45° field of view.
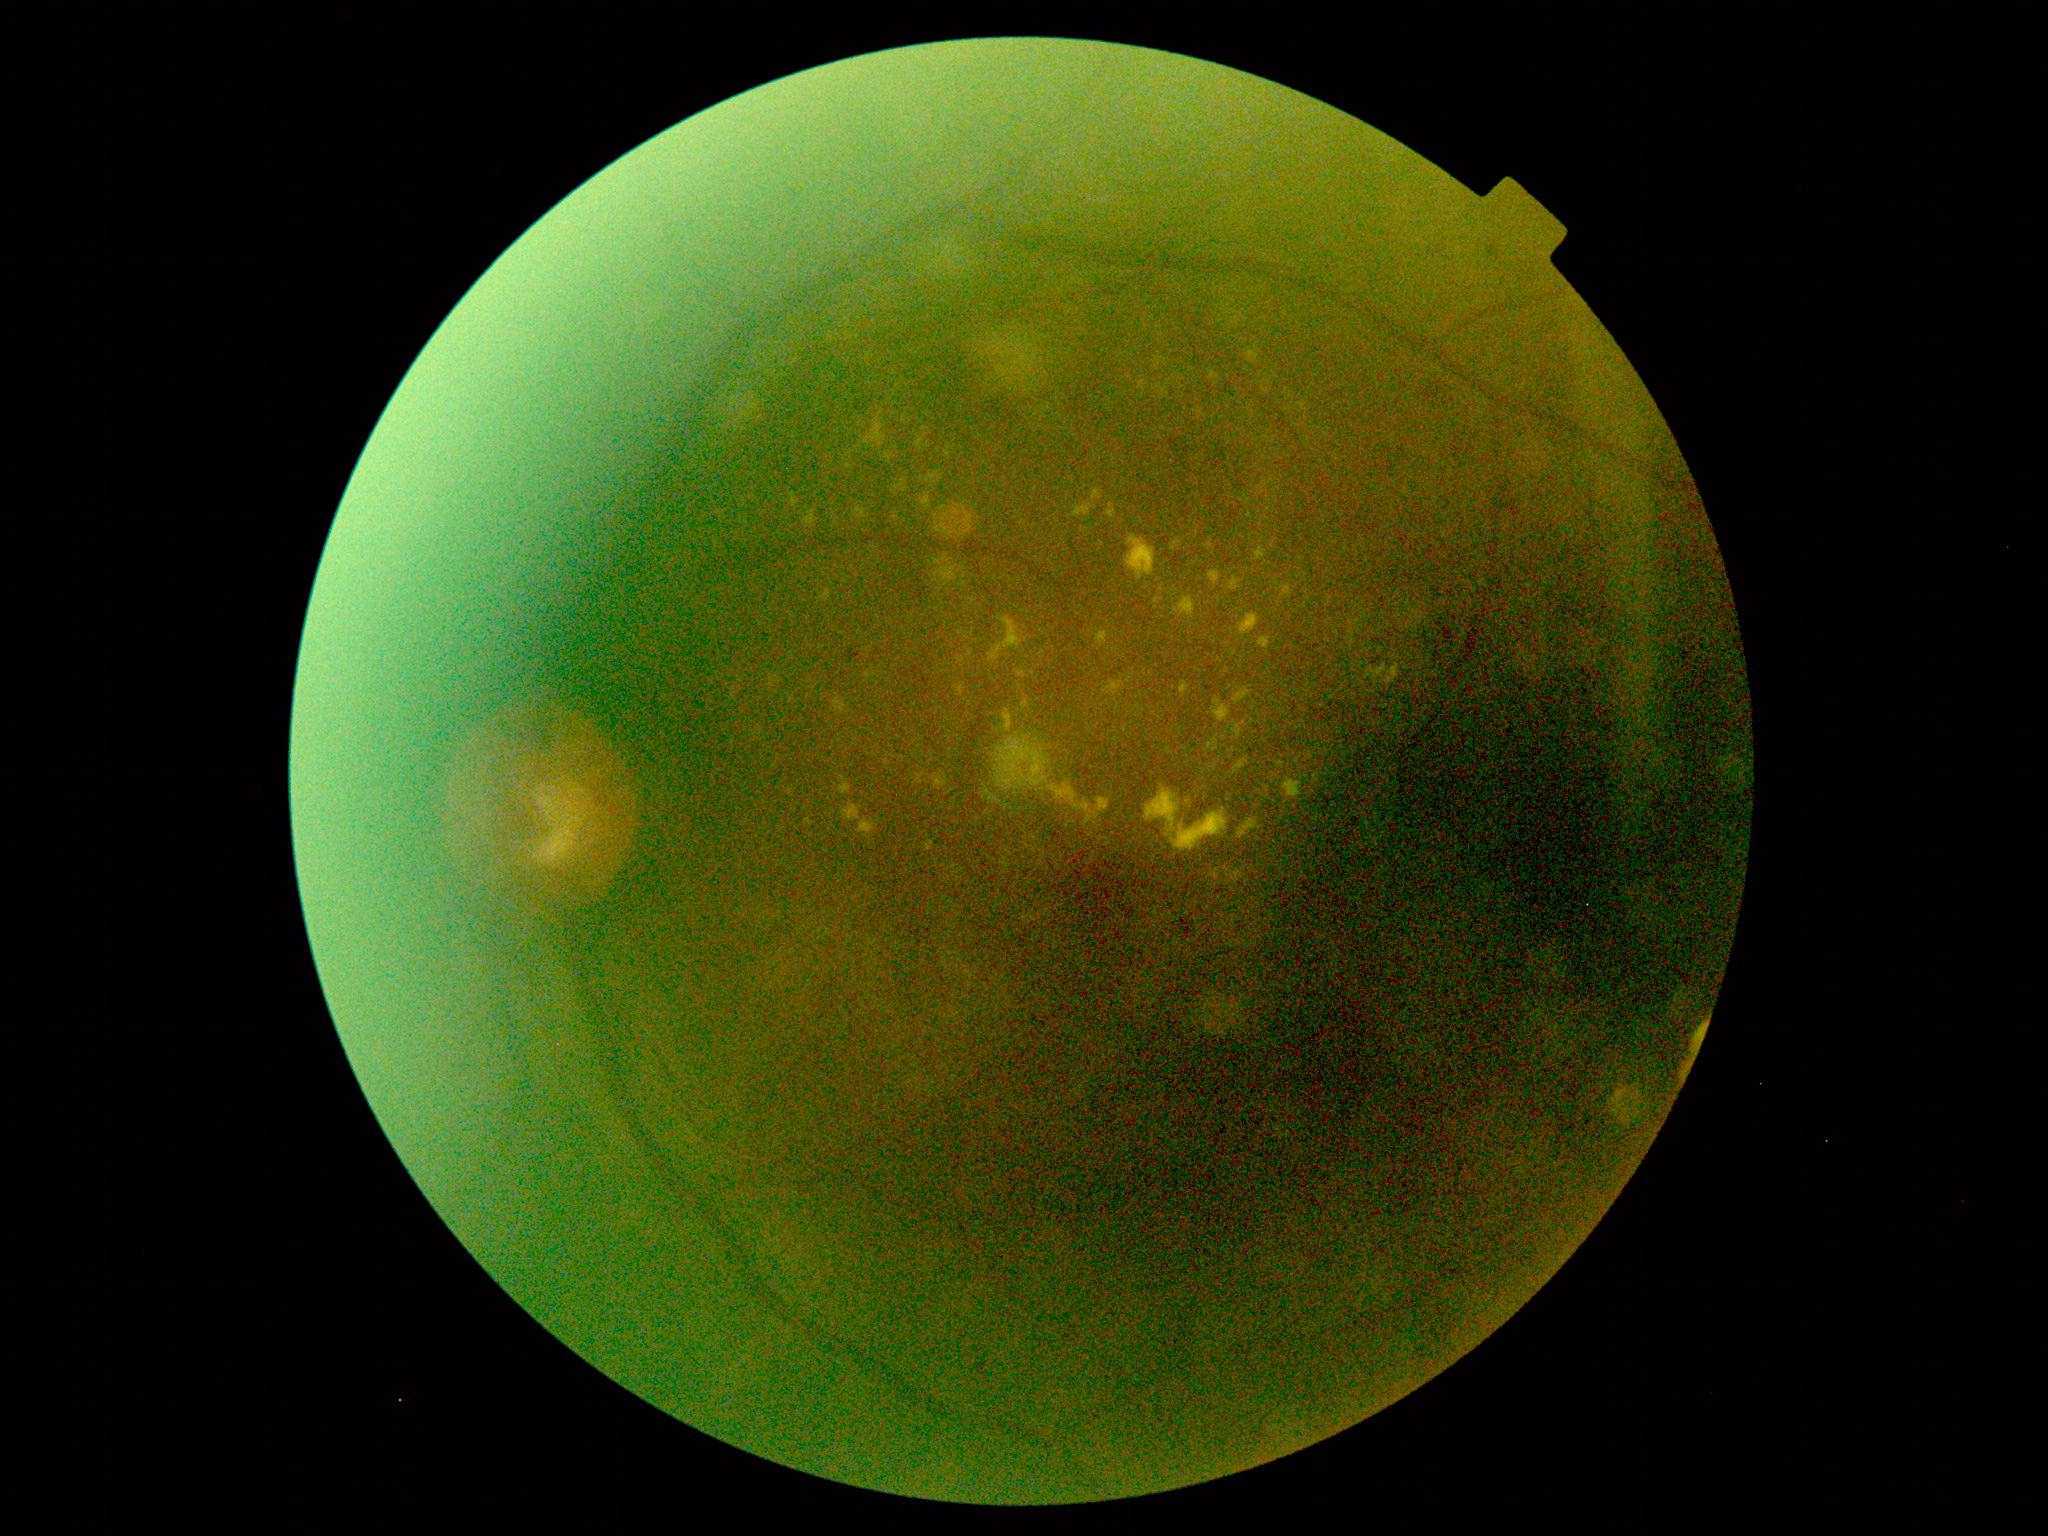 DR severity is grade 2 (moderate NPDR).